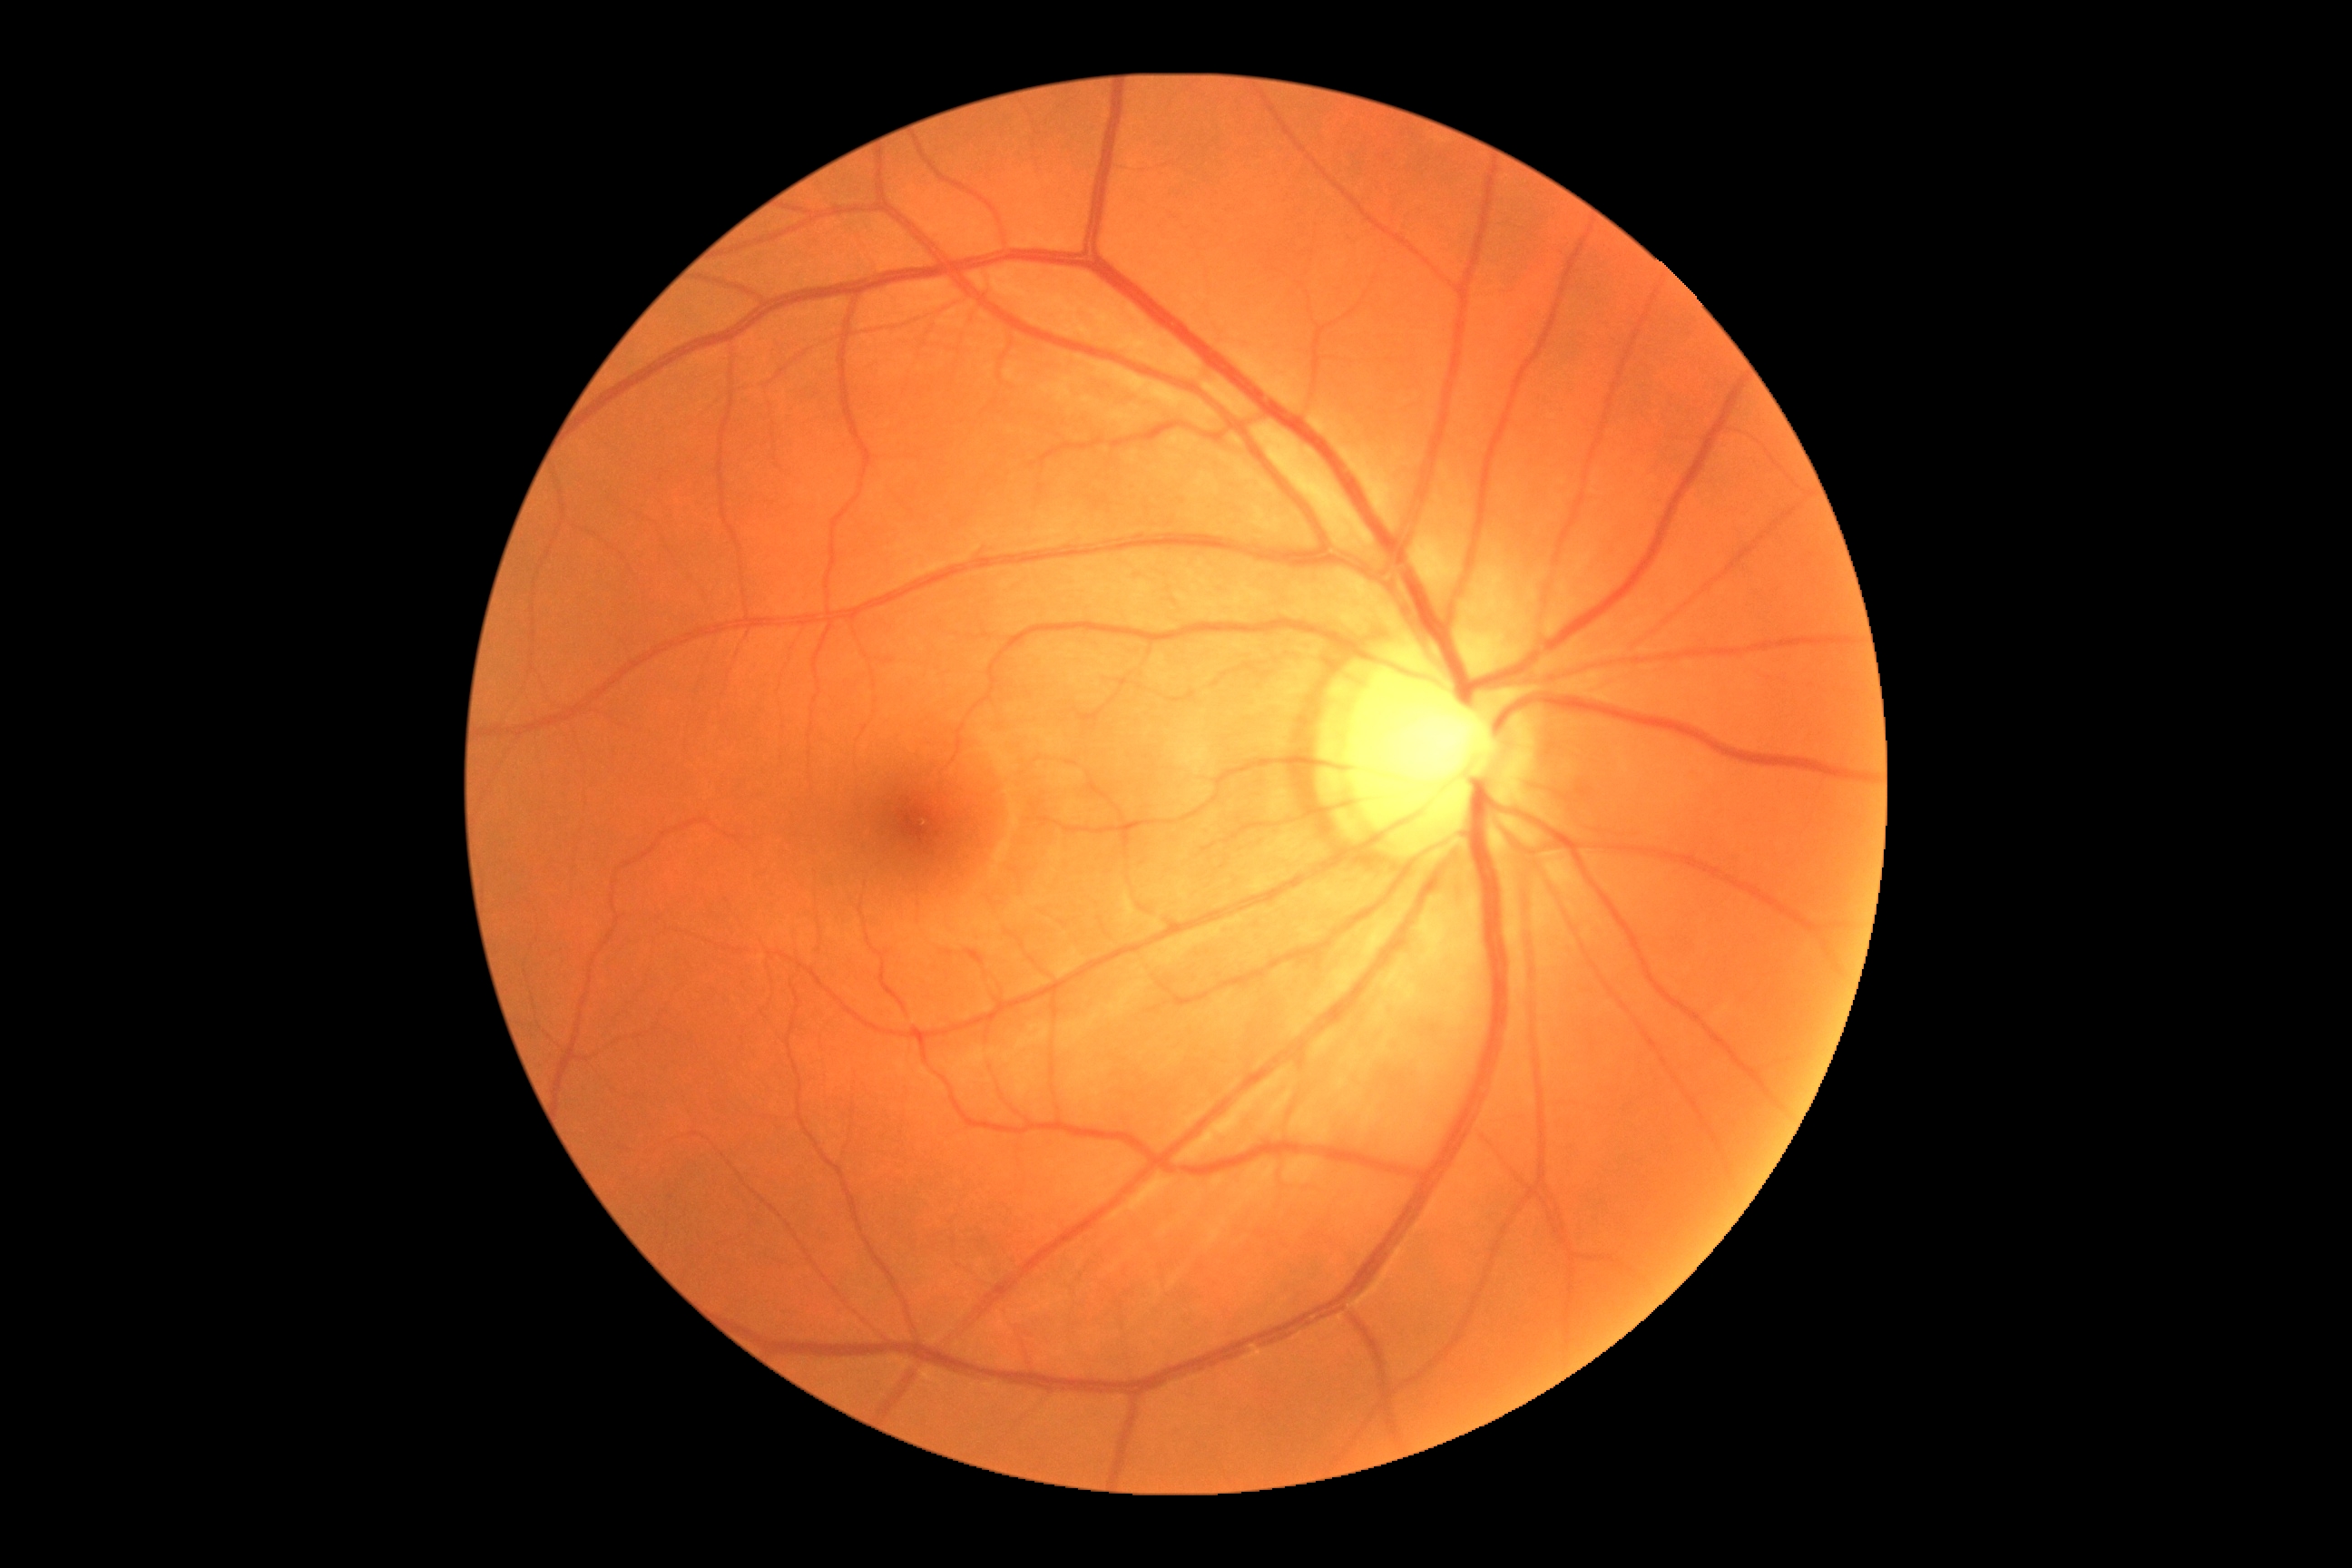 * DR impression — negative for DR
* retinopathy grade — 0 (no apparent retinopathy)